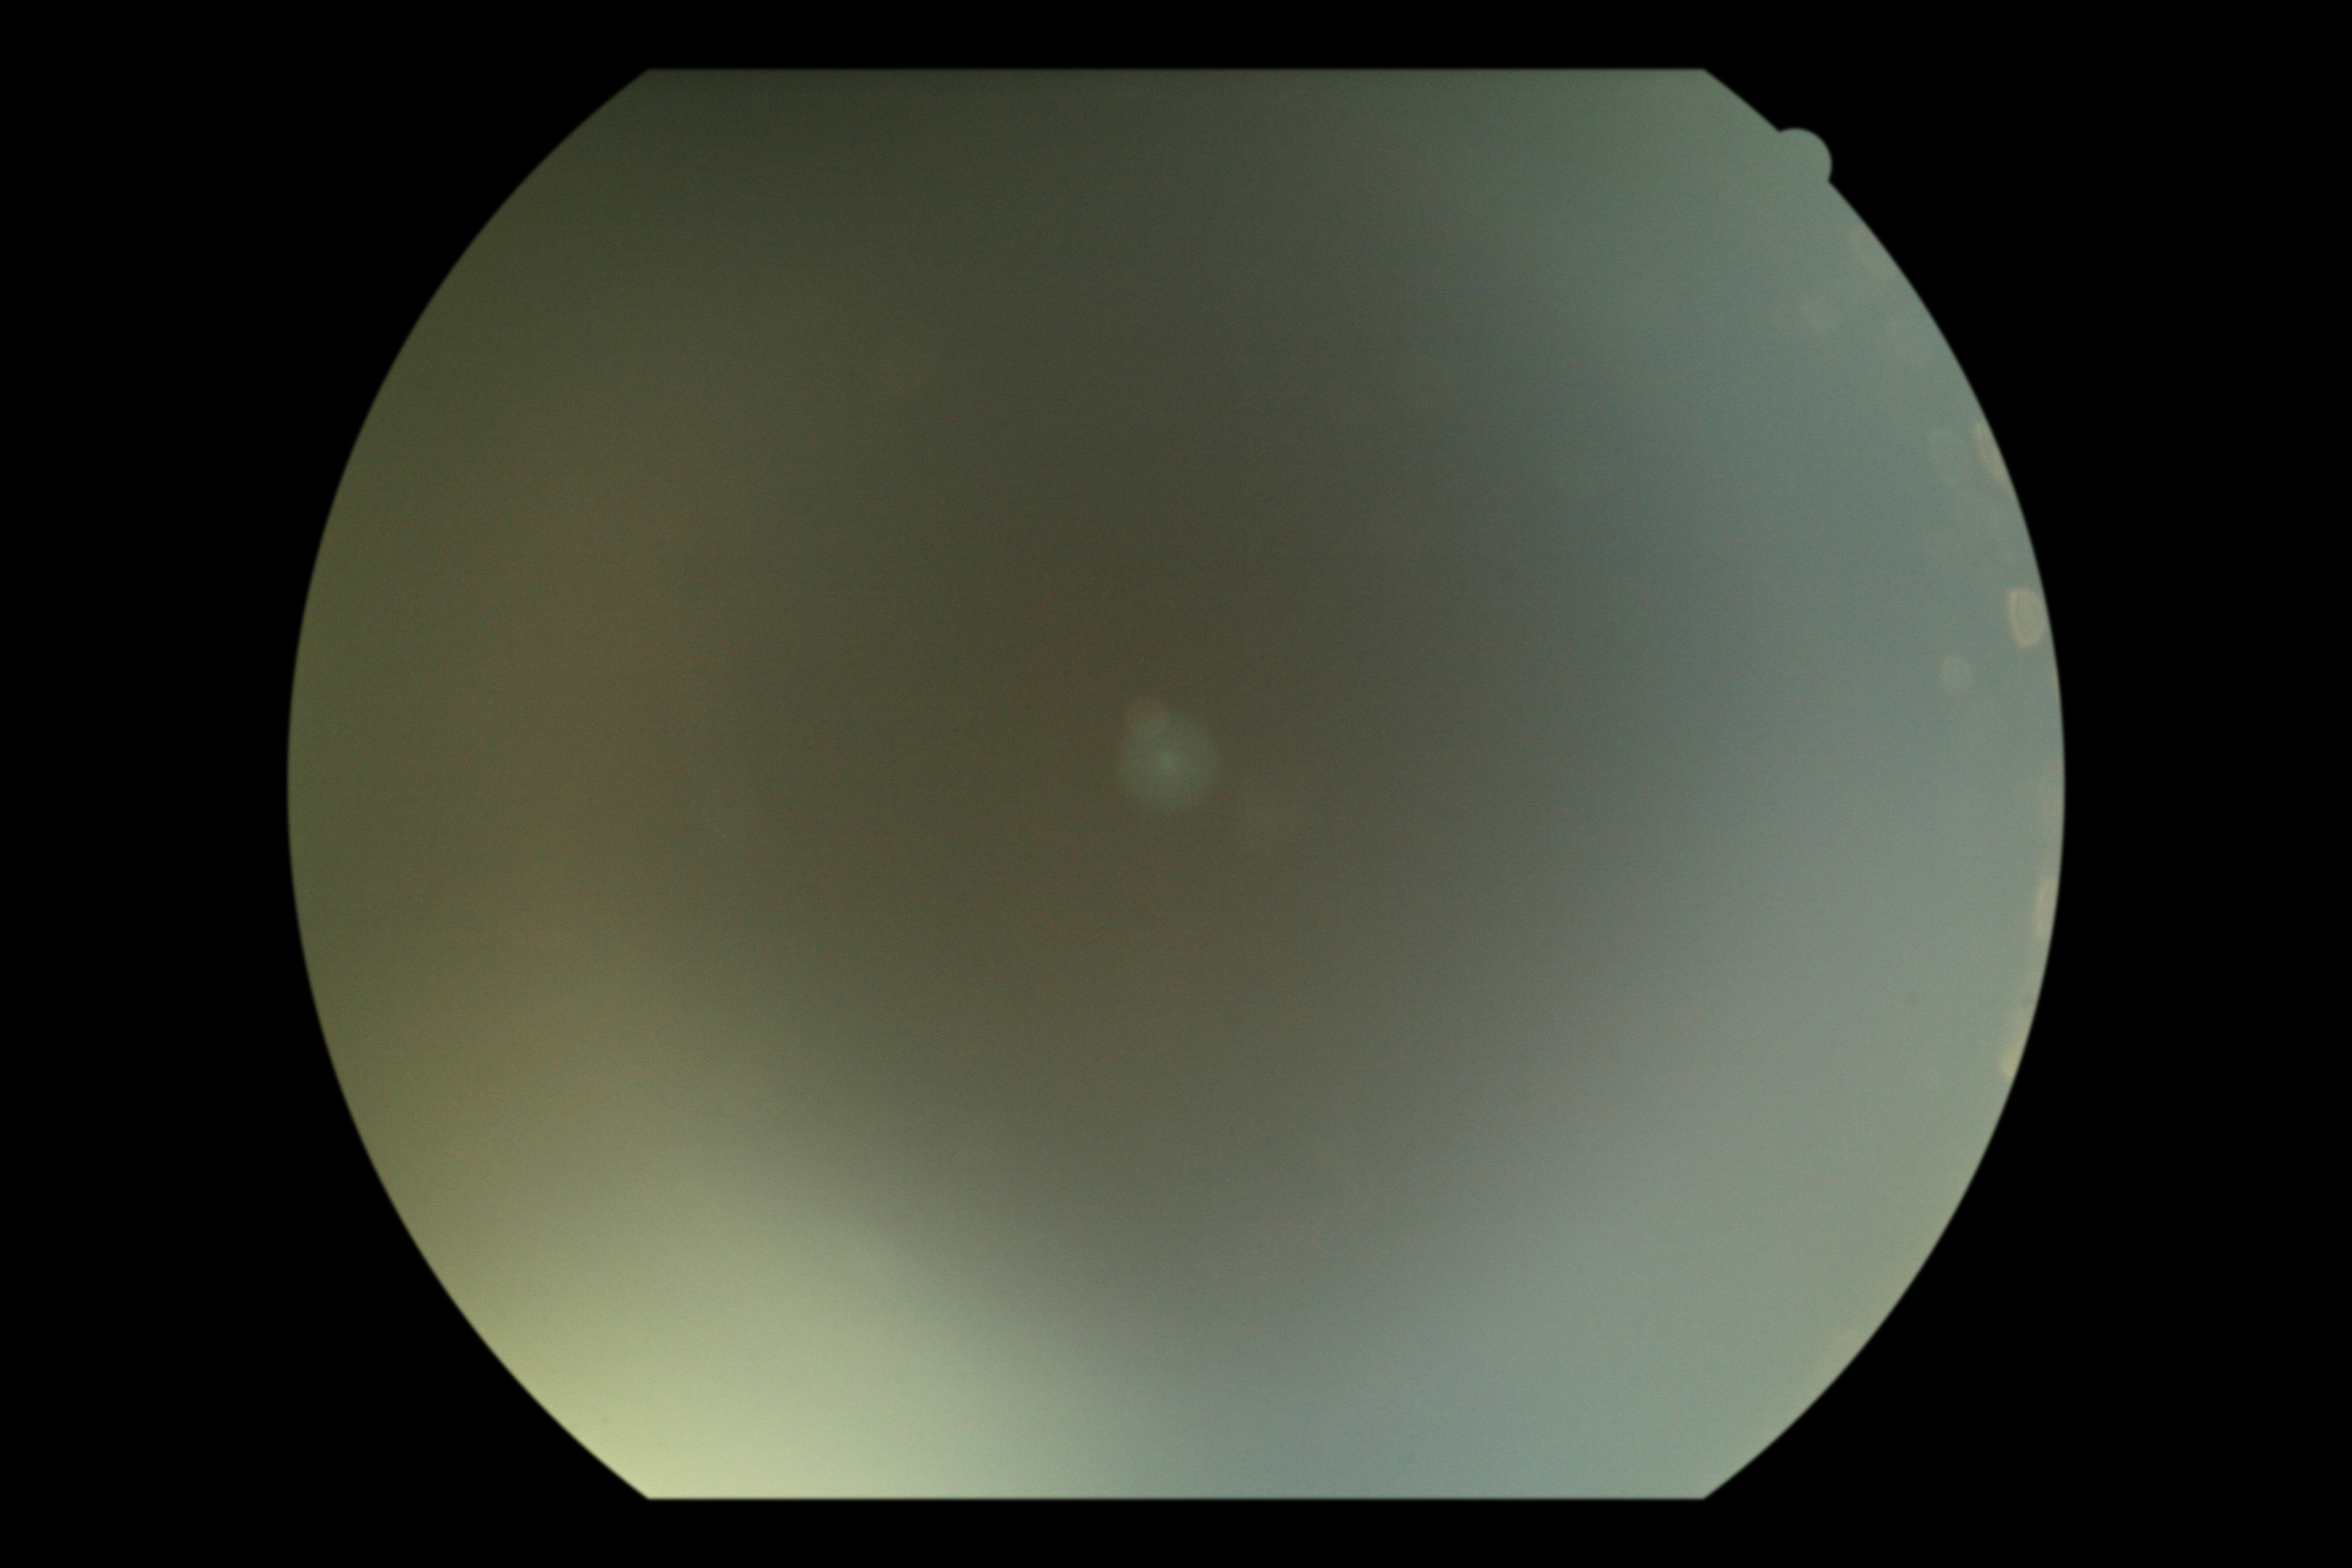

The image cannot be graded for diabetic retinopathy. DR grade is ungradable.